640x480px. Clarity RetCam 3, 130° FOV. Pediatric retinal photograph (wide-field) — 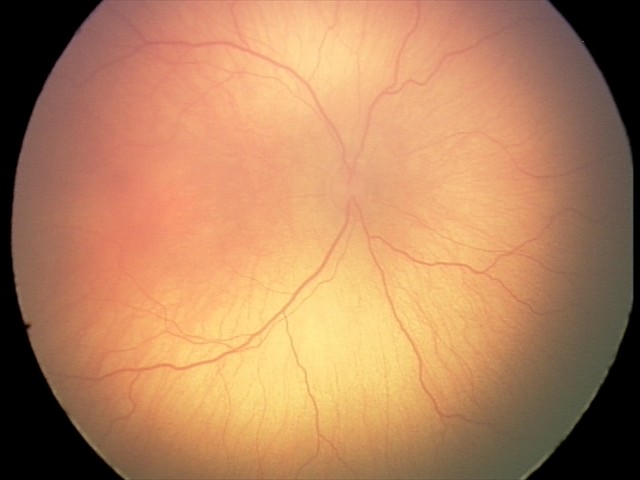

Screening series with retinopathy of prematurity stage 1. No plus disease.